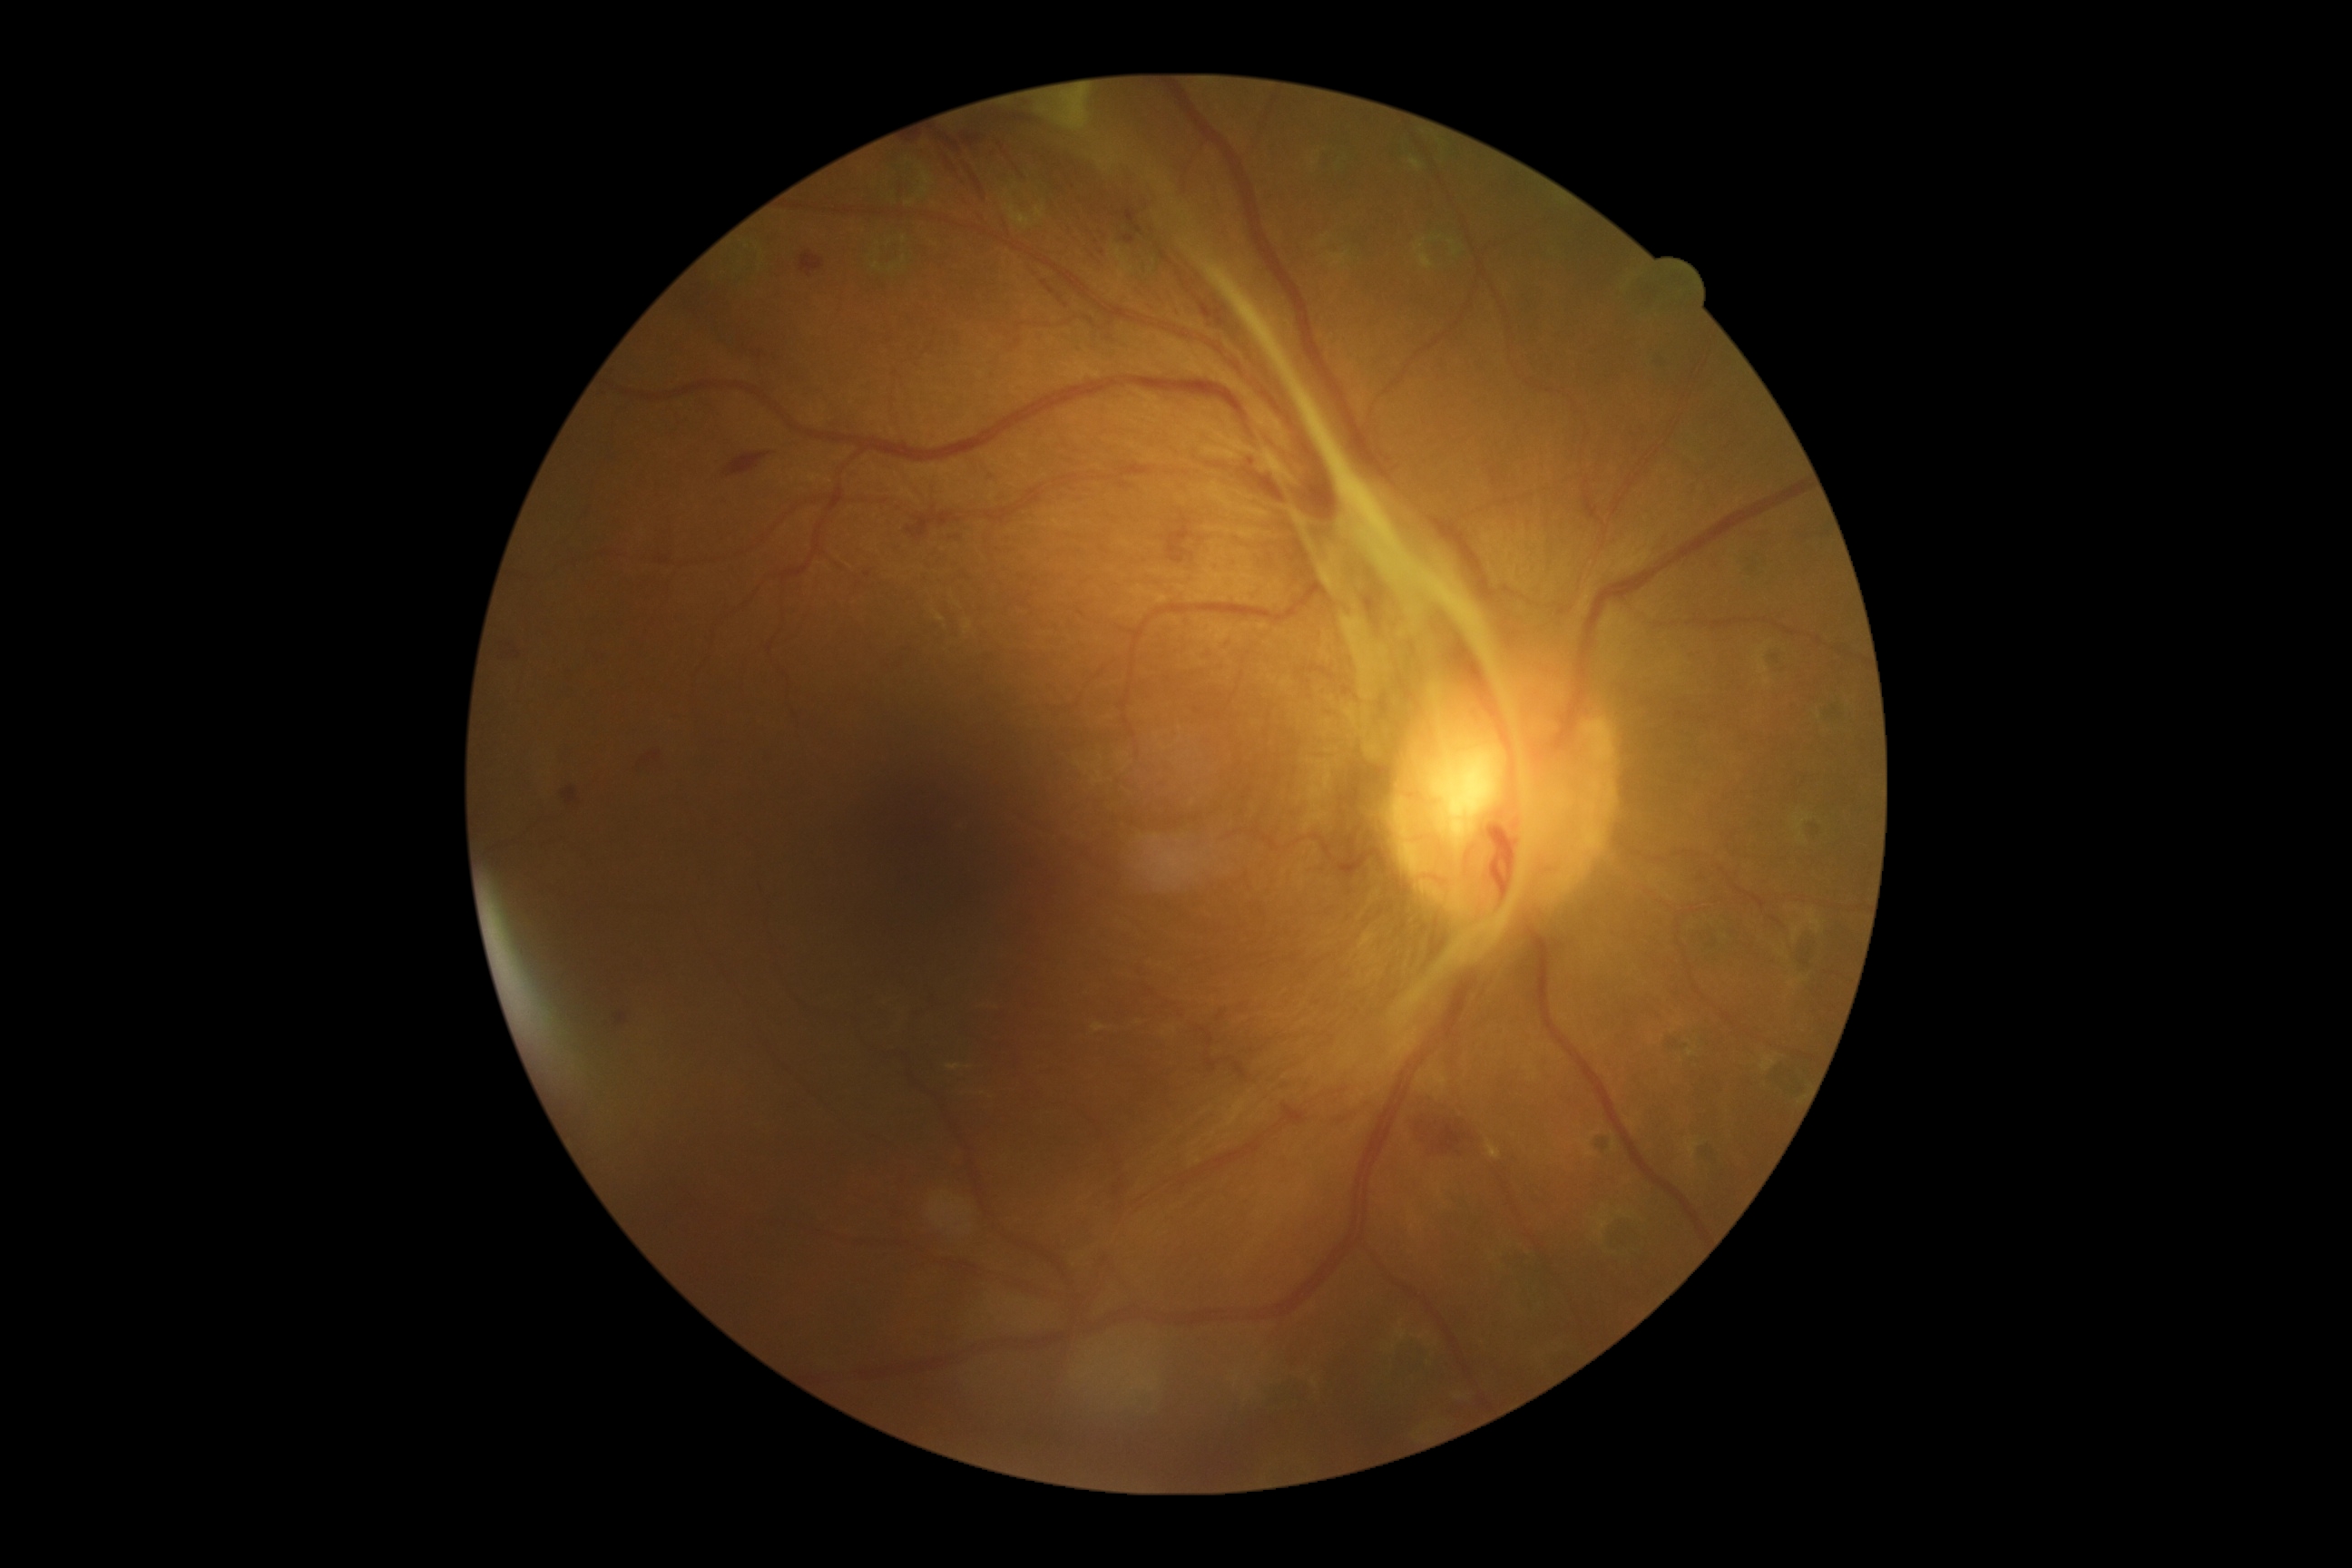

• diabetic retinopathy (DR) — grade 4 (PDR)